Pediatric wide-field fundus photograph · 1240x1240px — 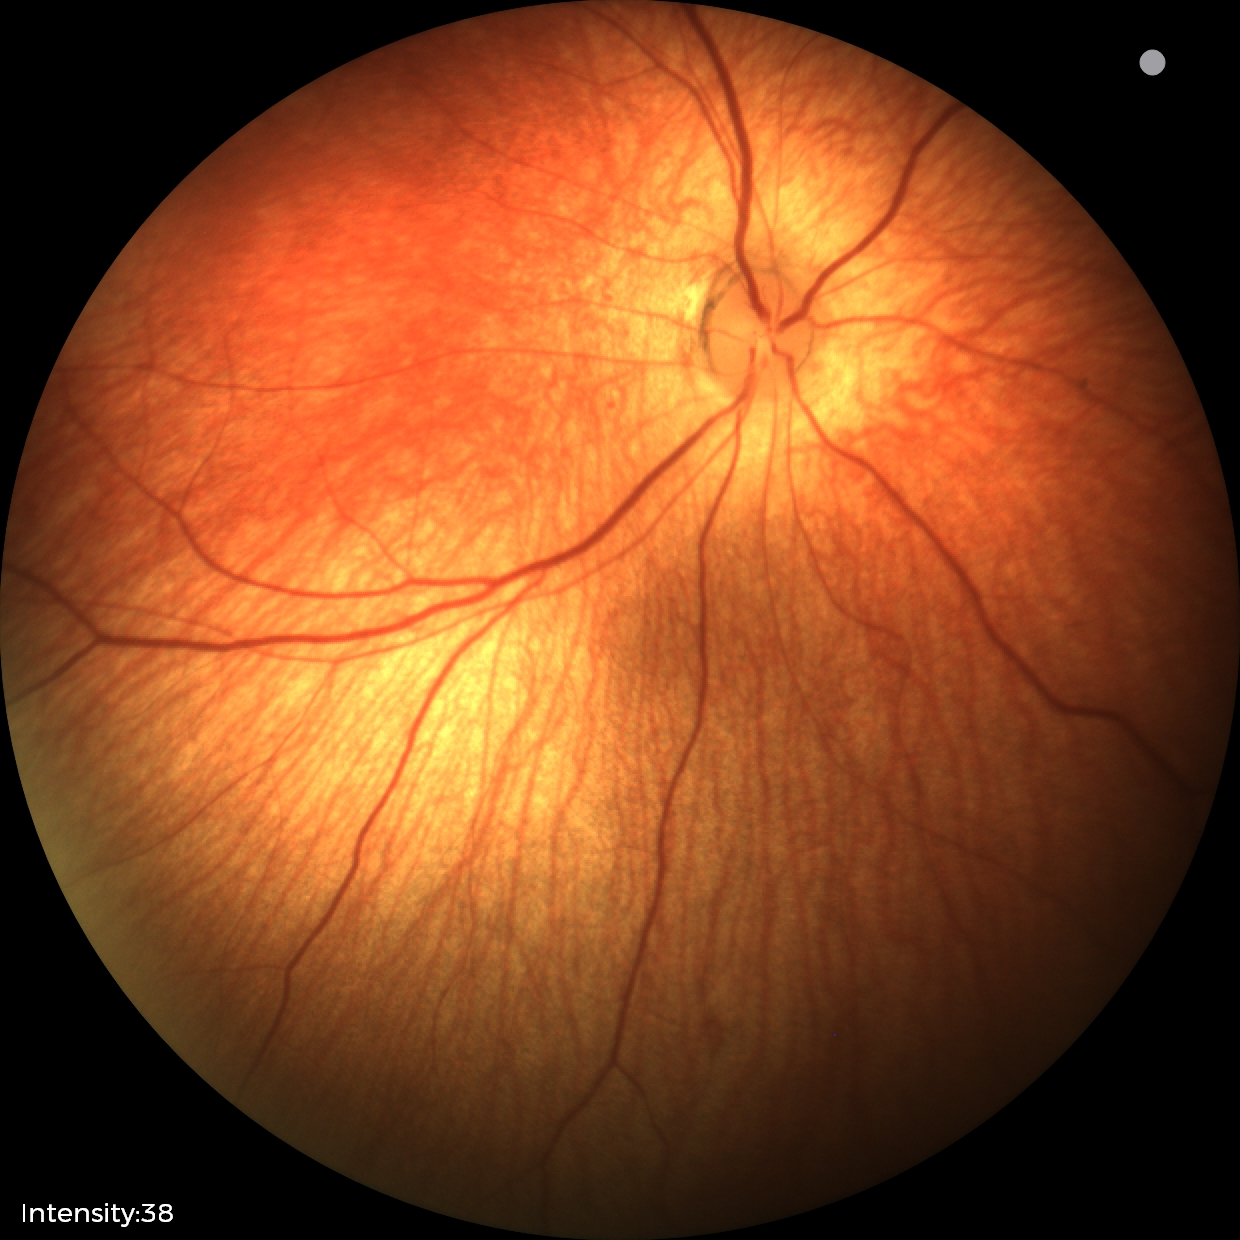

Physiological retinal appearance for postconceptual age.